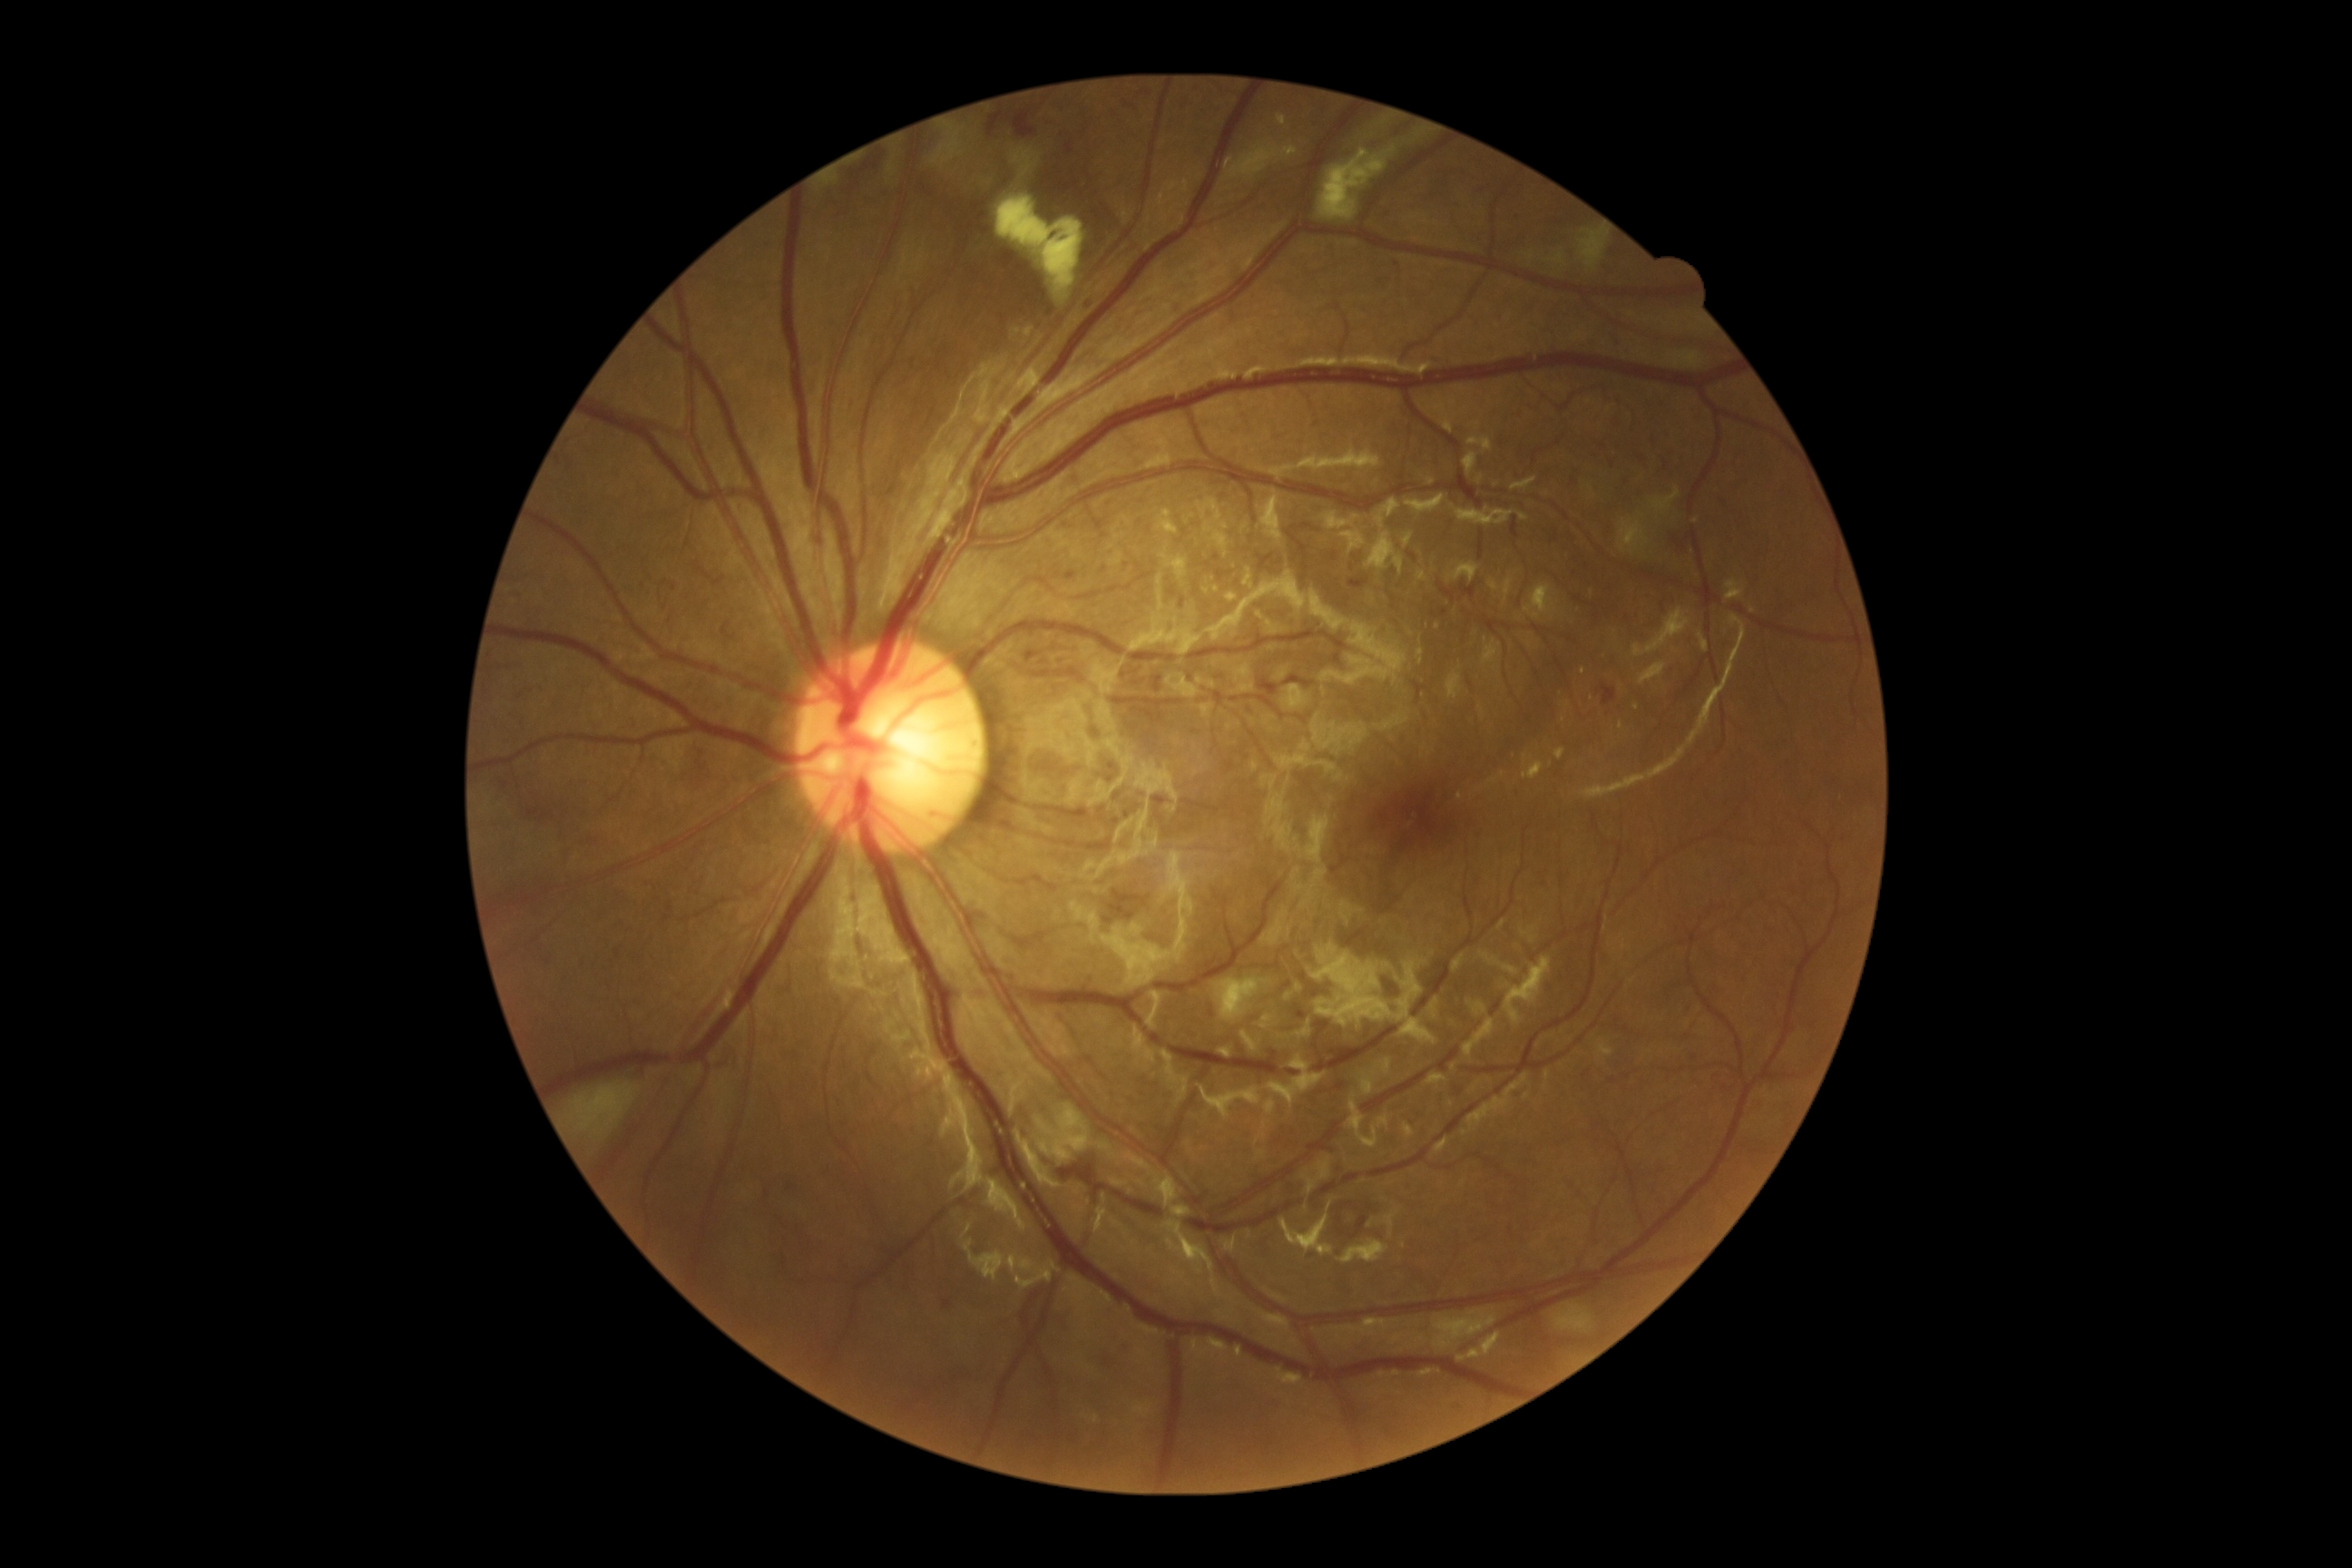

Diabetic retinopathy (DR) is 2; non-proliferative diabetic retinopathy. Hard exudates (EXs) are present, including at [left=1435, top=623, right=1440, bottom=631], [left=1554, top=749, right=1565, bottom=760], [left=1257, top=611, right=1264, bottom=620], [left=1279, top=115, right=1288, bottom=126], [left=1415, top=618, right=1427, bottom=643], [left=1157, top=509, right=1179, bottom=536], [left=1213, top=585, right=1219, bottom=593]. EXs (small, approximate centers) near [1568, 704], [1292, 153], [1583, 671], [1207, 591], [1563, 719]. Soft exudates (SEs) identified at [left=997, top=197, right=1084, bottom=304], [left=997, top=150, right=1037, bottom=195], [left=562, top=1083, right=640, bottom=1148], [left=1547, top=253, right=1565, bottom=264], [left=1536, top=593, right=1549, bottom=620], [left=1318, top=146, right=1398, bottom=220], [left=1580, top=231, right=1609, bottom=270], [left=1215, top=981, right=1271, bottom=1017]. Hemorrhages (HEs) identified at [left=1284, top=676, right=1315, bottom=687], [left=1349, top=580, right=1369, bottom=589], [left=1014, top=112, right=1037, bottom=139], [left=1059, top=1150, right=1099, bottom=1186], [left=1259, top=678, right=1279, bottom=696], [left=1026, top=651, right=1039, bottom=663], [left=1602, top=683, right=1616, bottom=705], [left=988, top=112, right=1008, bottom=137], [left=852, top=155, right=883, bottom=186]. Microaneurysms (MAs) are present, including at [left=1066, top=571, right=1077, bottom=580], [left=1066, top=142, right=1073, bottom=155], [left=1086, top=293, right=1092, bottom=308], [left=943, top=1298, right=954, bottom=1309], [left=1295, top=1004, right=1308, bottom=1021]. MAs (small, approximate centers) near [790, 1187], [520, 697], [618, 953], [1396, 265].